Color fundus photograph from a handheld portable camera · 2212x1659.
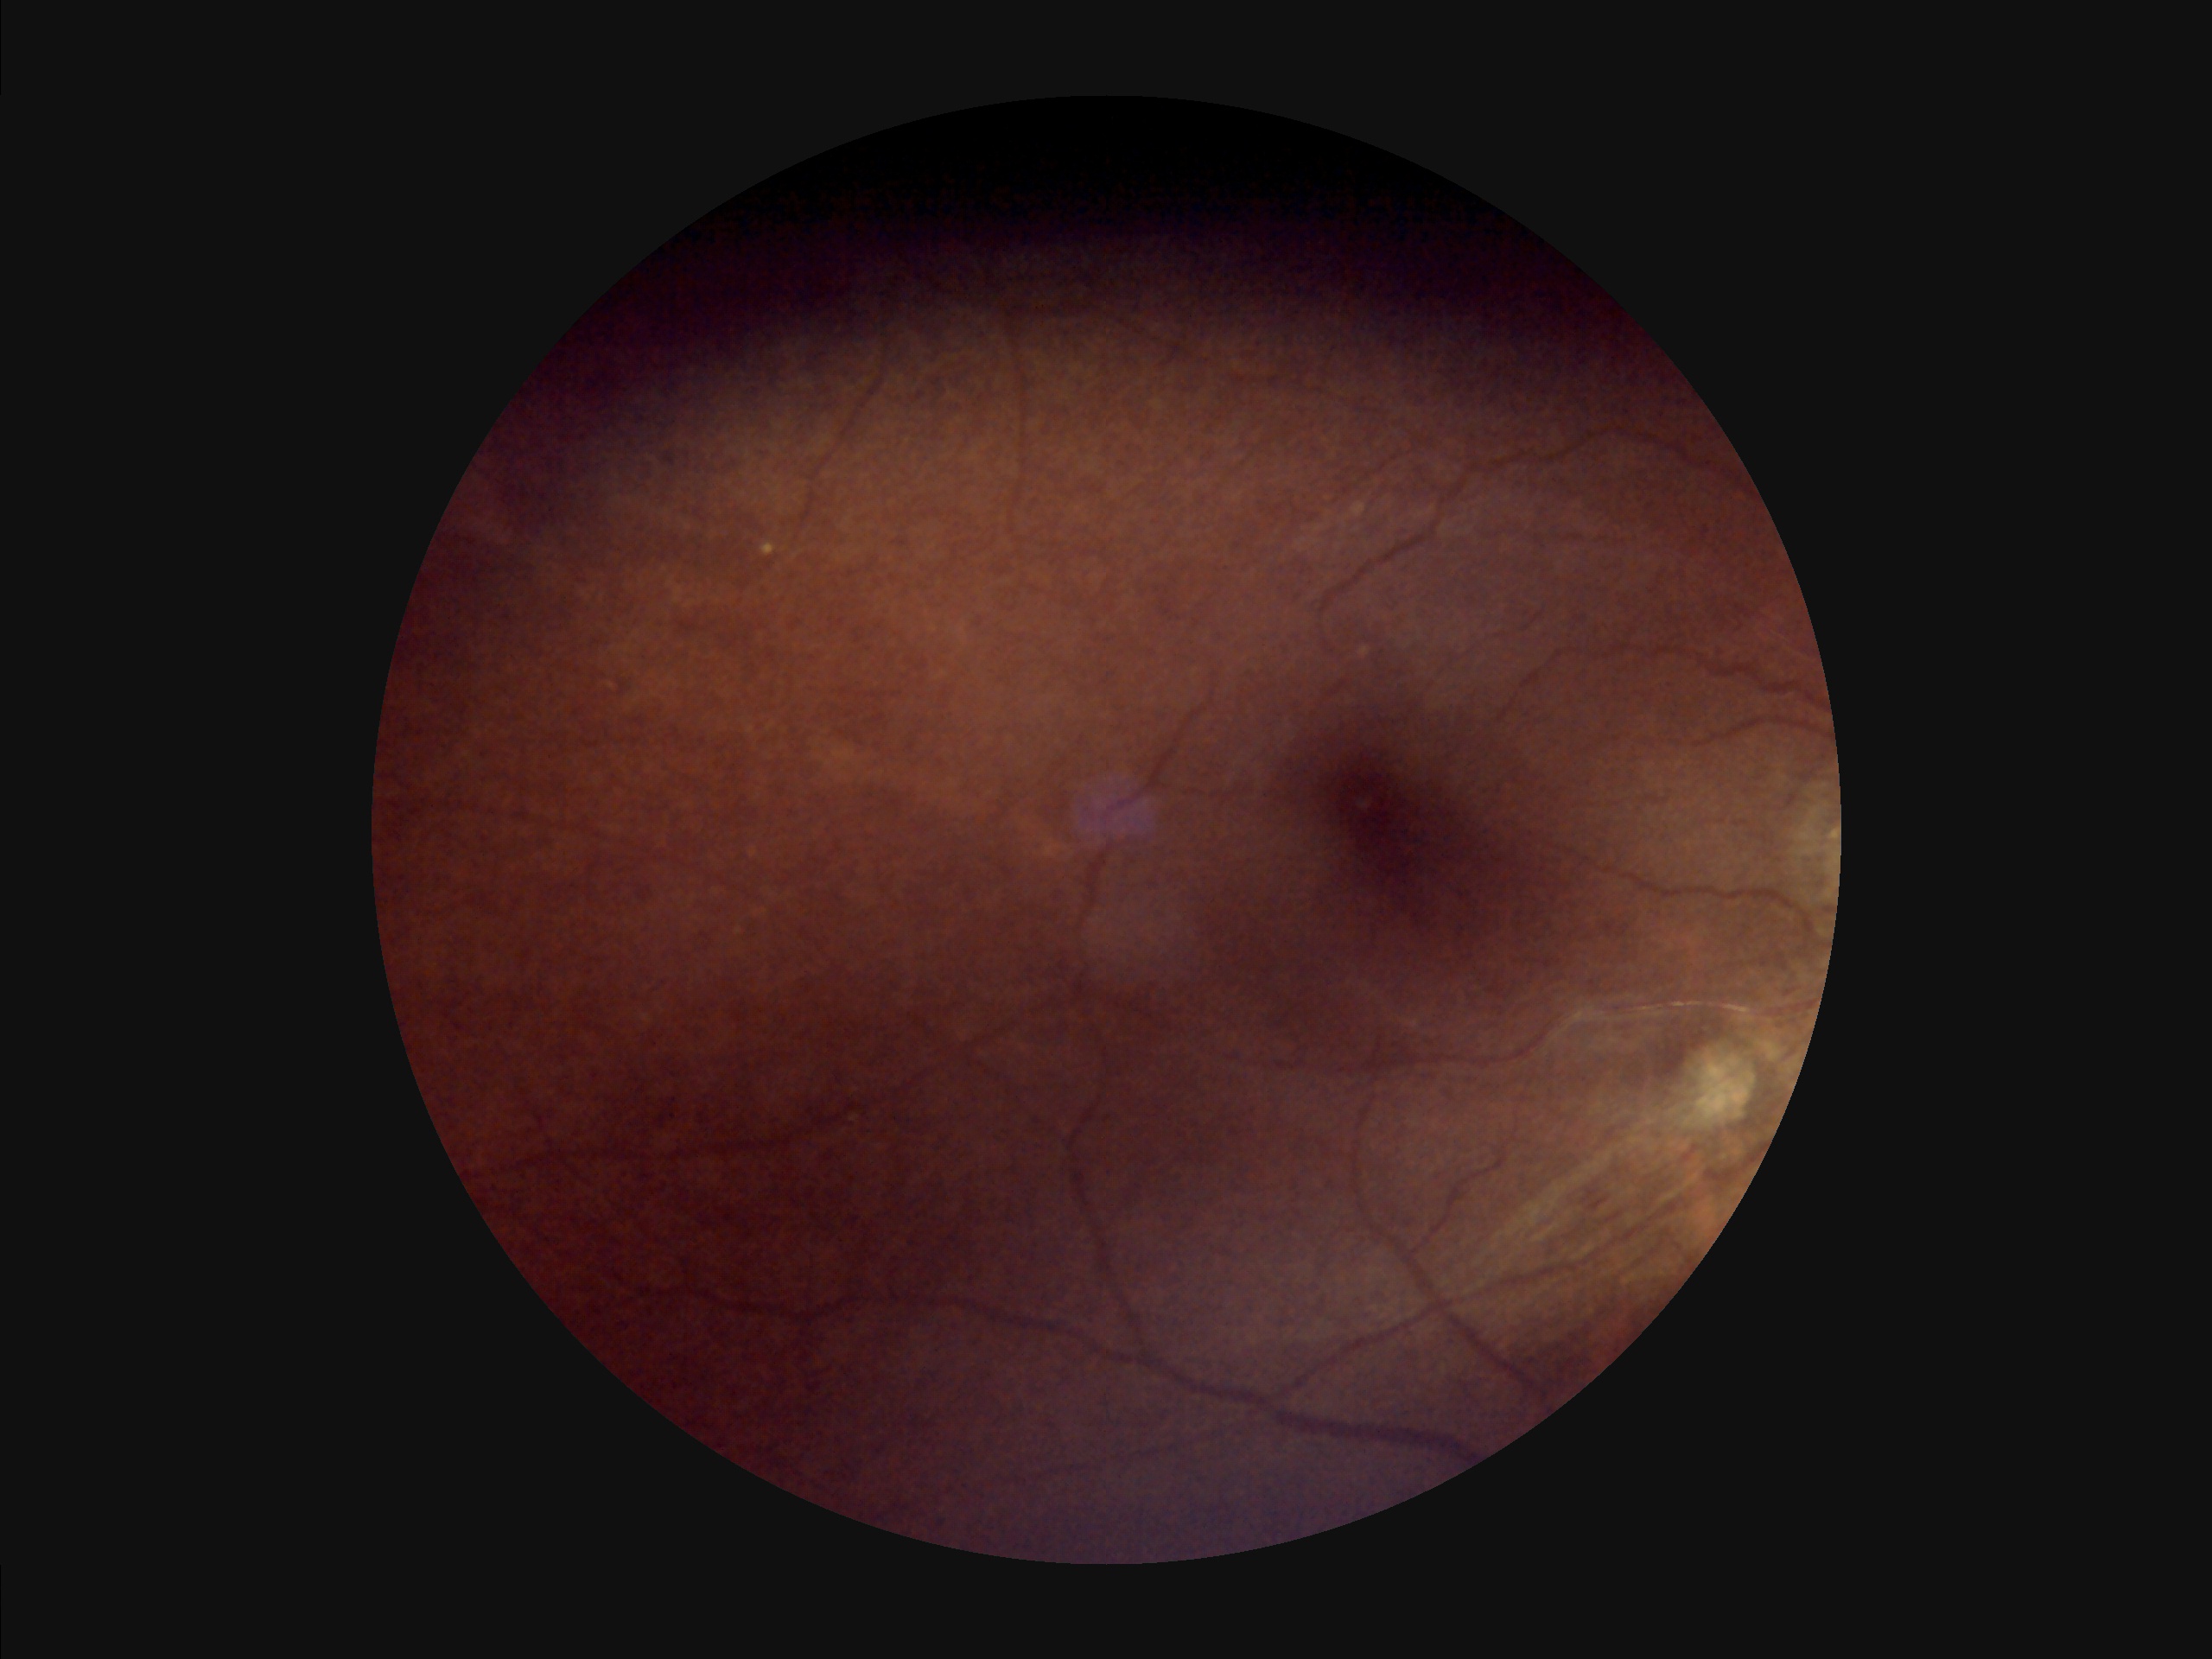
{"contrast": "reduced", "clarity": "out of focus", "overall_quality": "poor", "illumination": "suboptimal"}